45-degree field of view
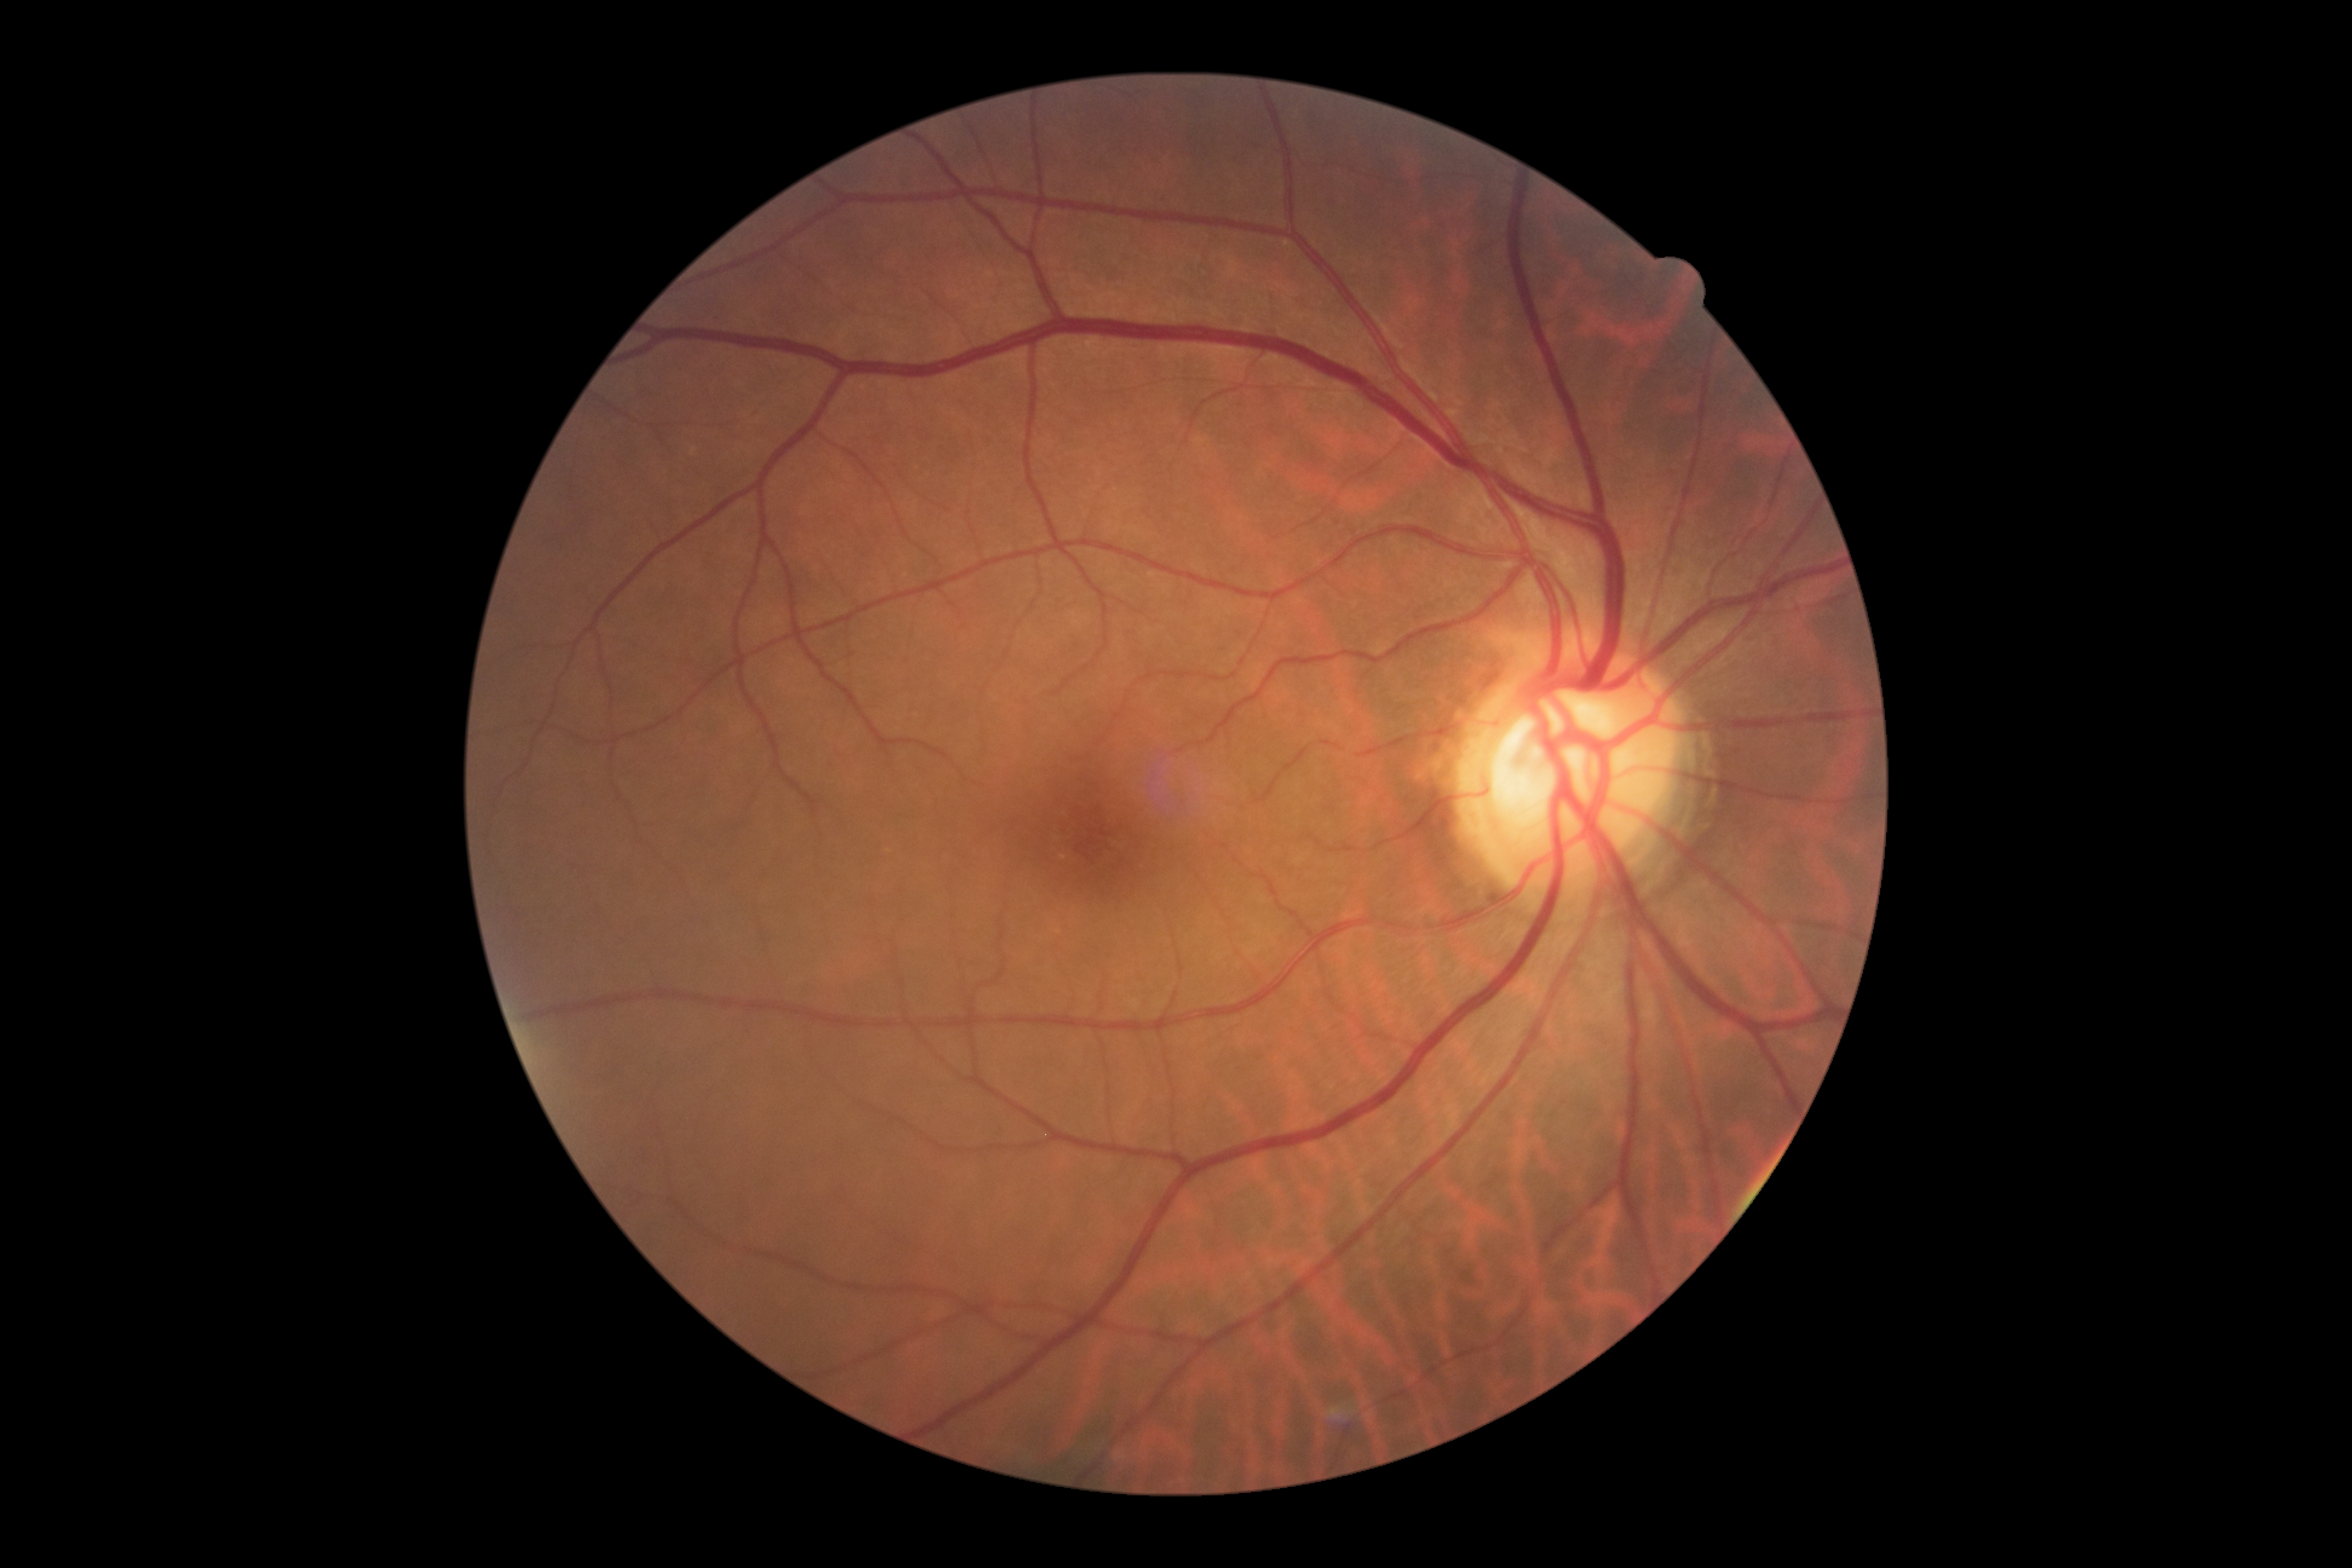
{"dr_grade": "grade 0"}